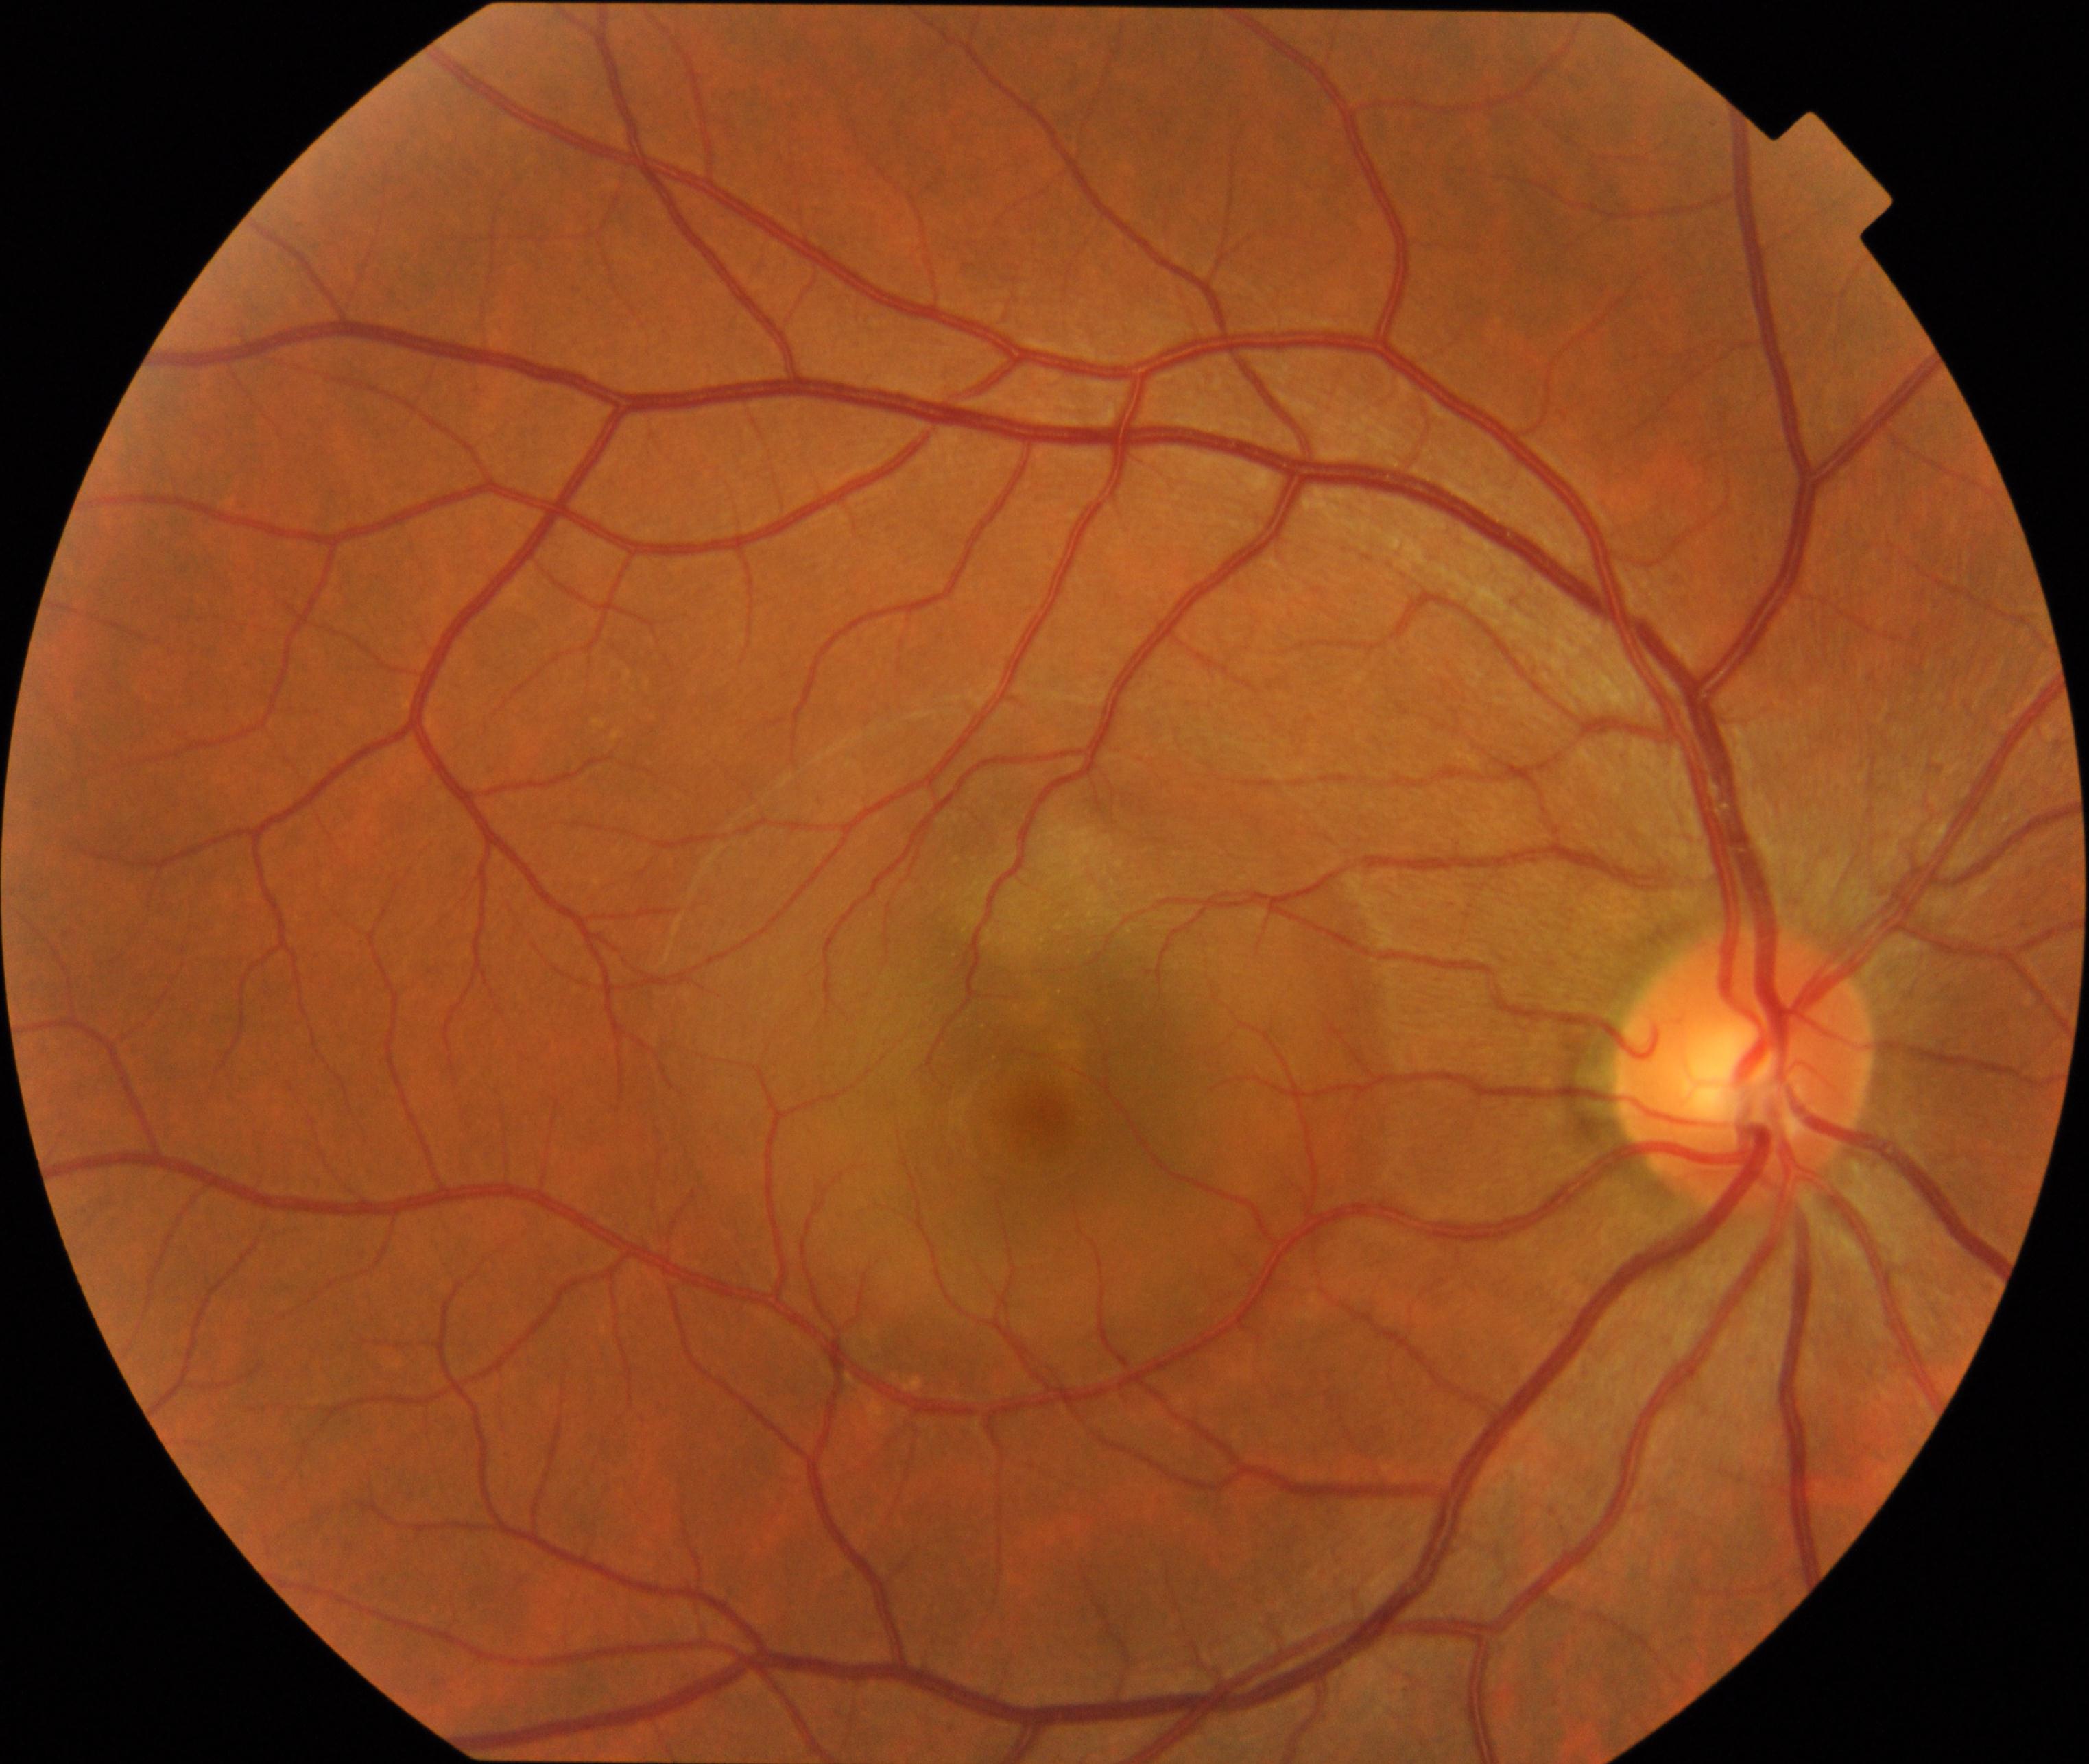
Diagnosis: central serous chorioretinopathy.